Fundus photo. Image size 240x240 — 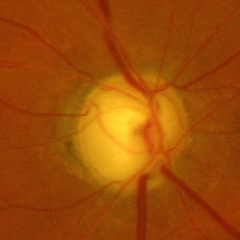
Glaucoma status = advanced glaucomatous optic neuropathy. Diagnostic criteria: near-total cupping of the optic nerve head, with or without severe visual field loss within the central 10 degrees of fixation.